Retinal fundus photograph: 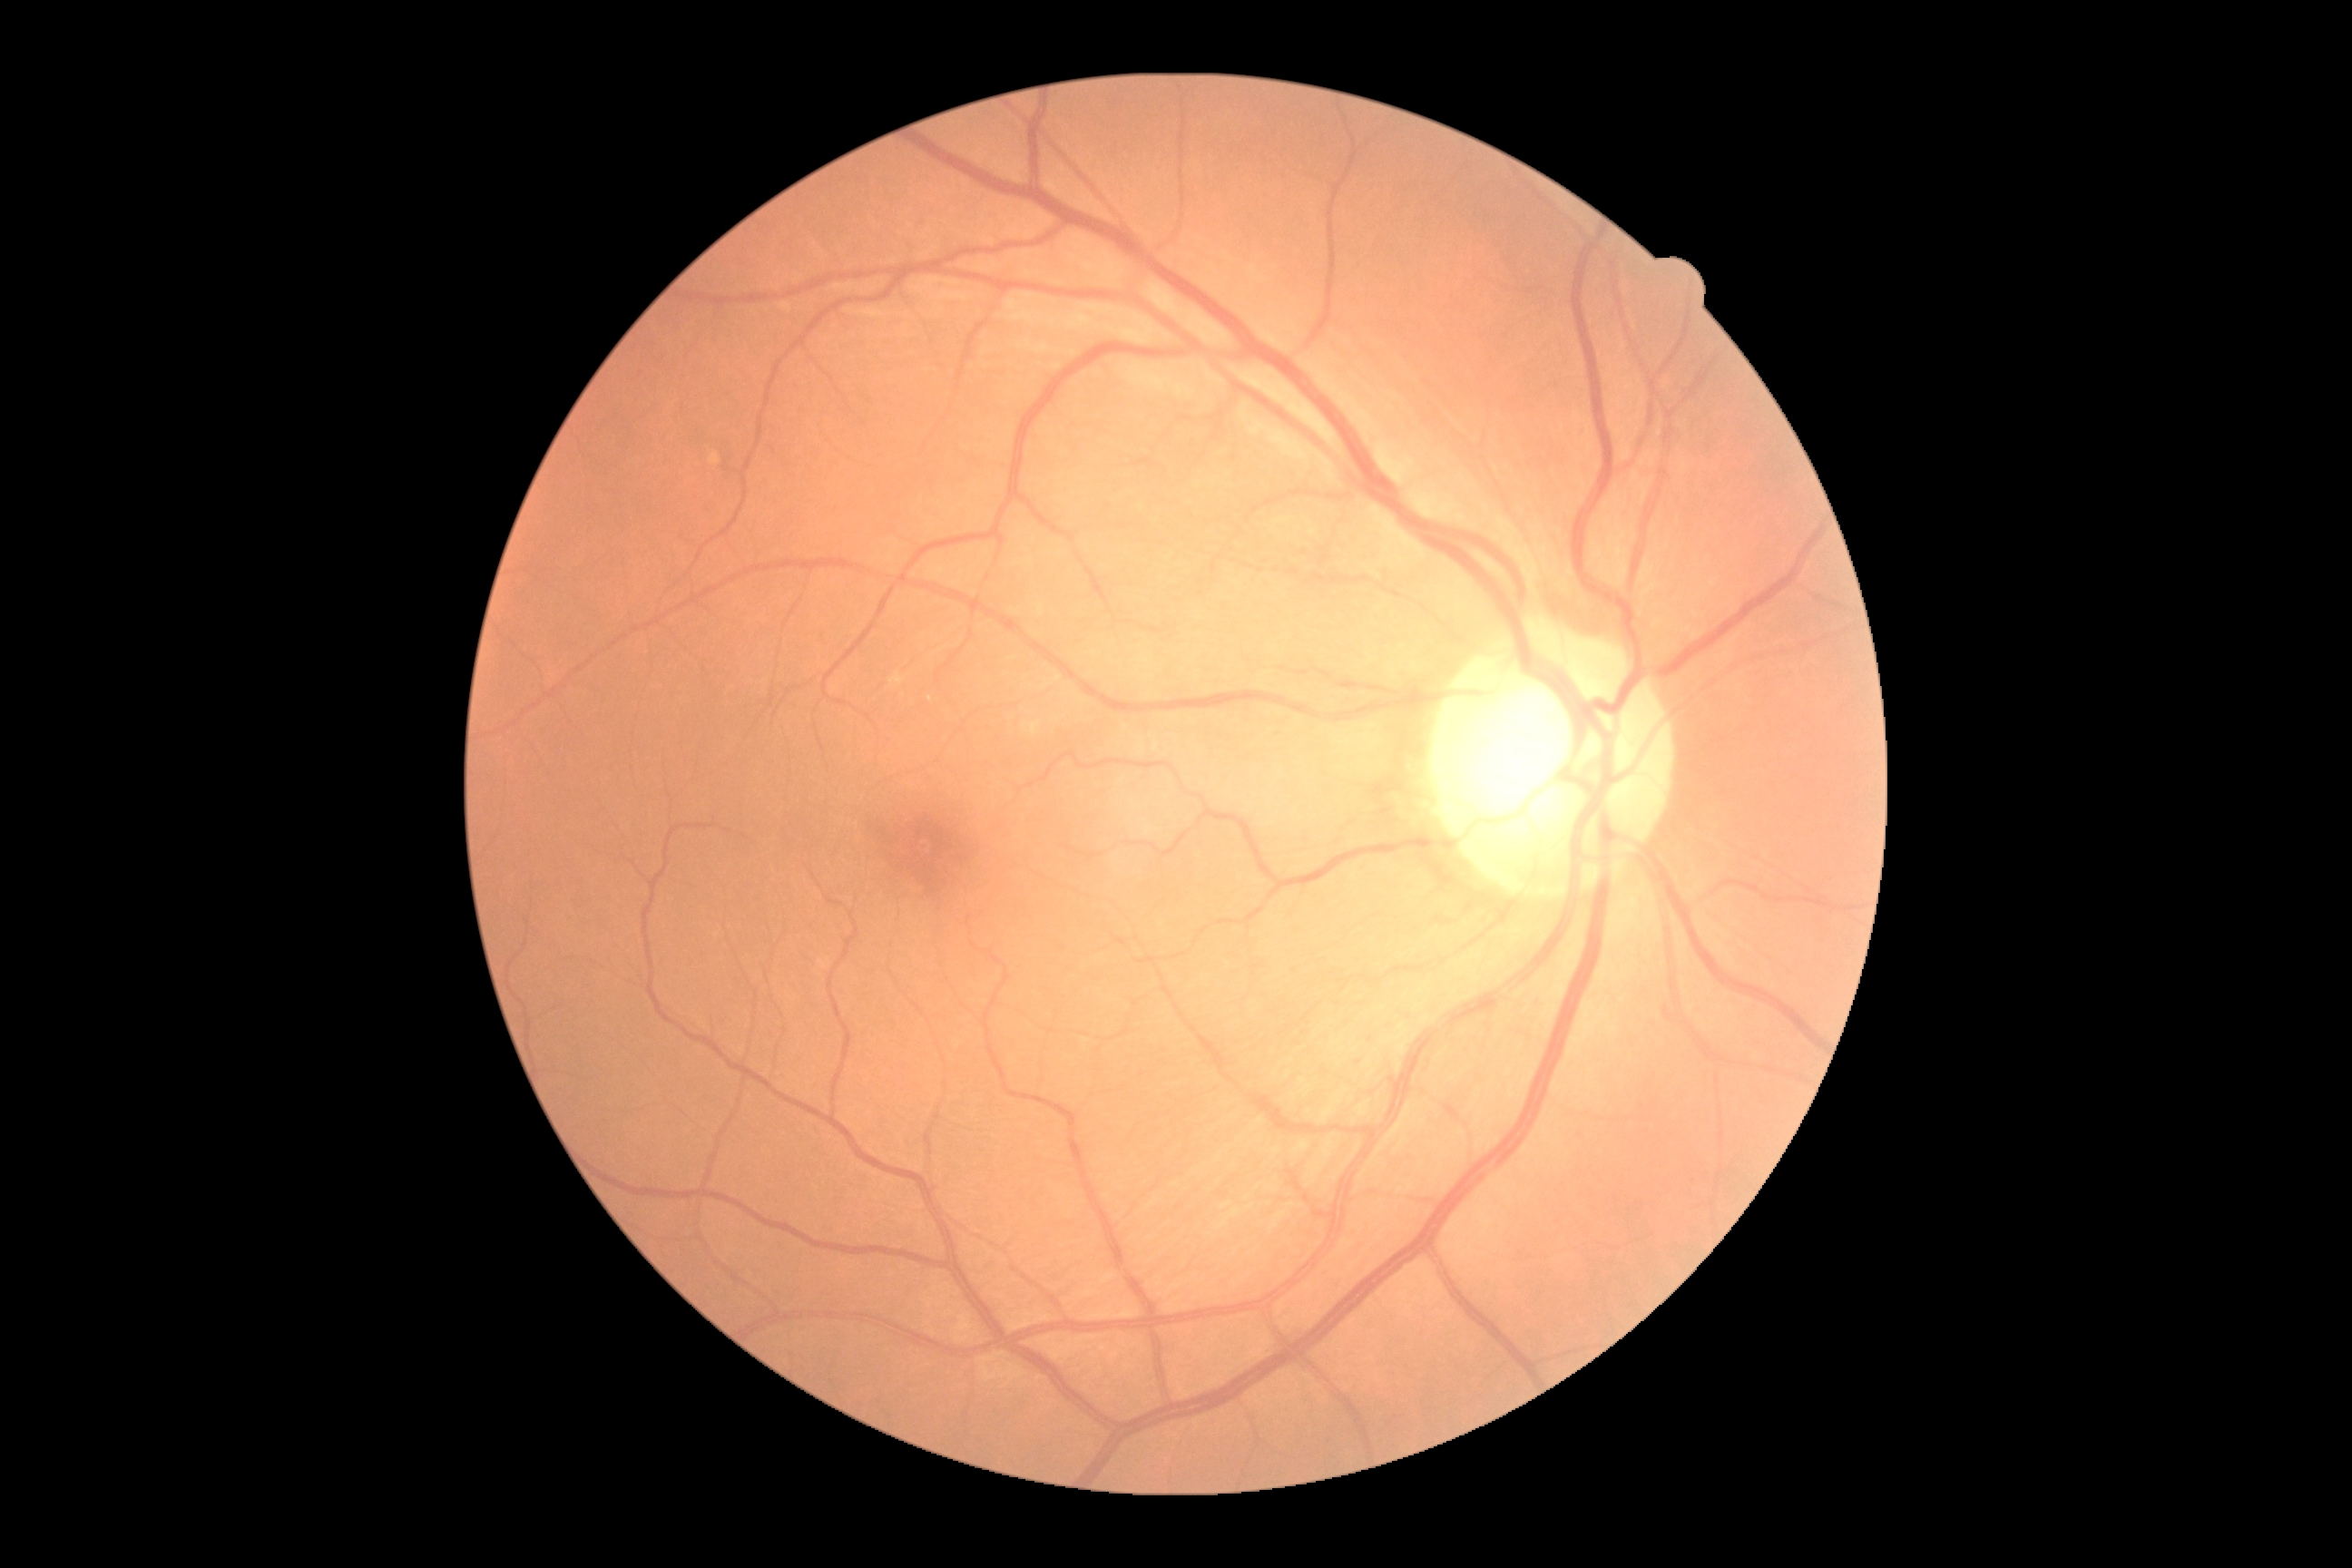

No apparent diabetic retinopathy. DR grade is 0/4.